Nonmydriatic fundus photograph, NIDEK AFC-230 fundus camera, retinal fundus photograph, DR severity per modified Davis staging: 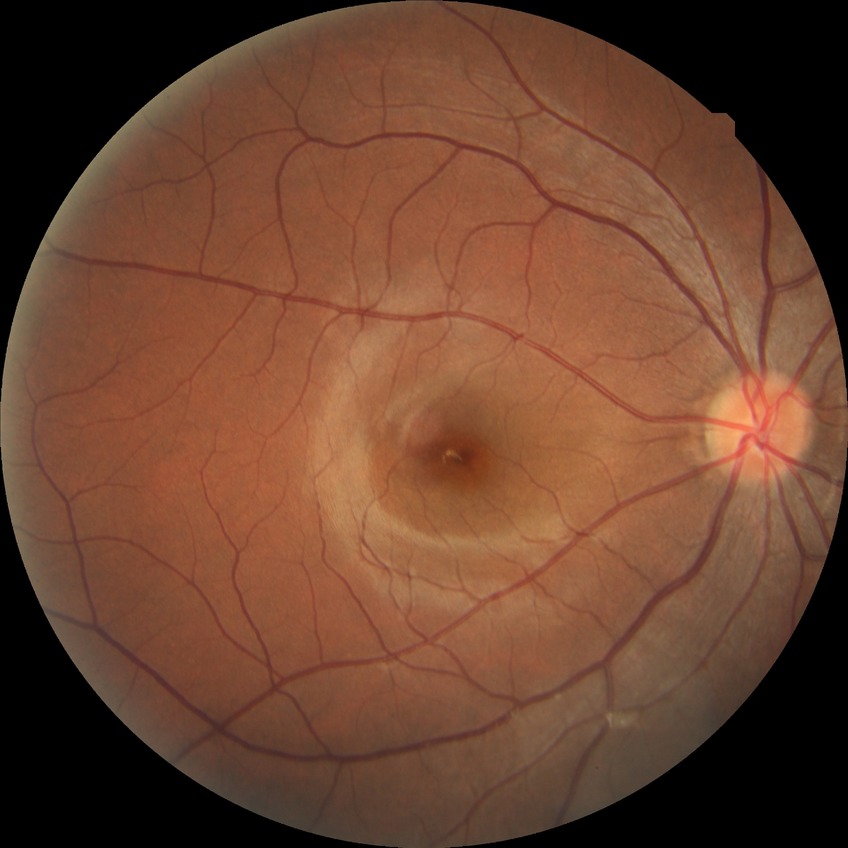 Davis grading = no diabetic retinopathy.